1725x1721; color fundus image; FOV: 45 degrees: 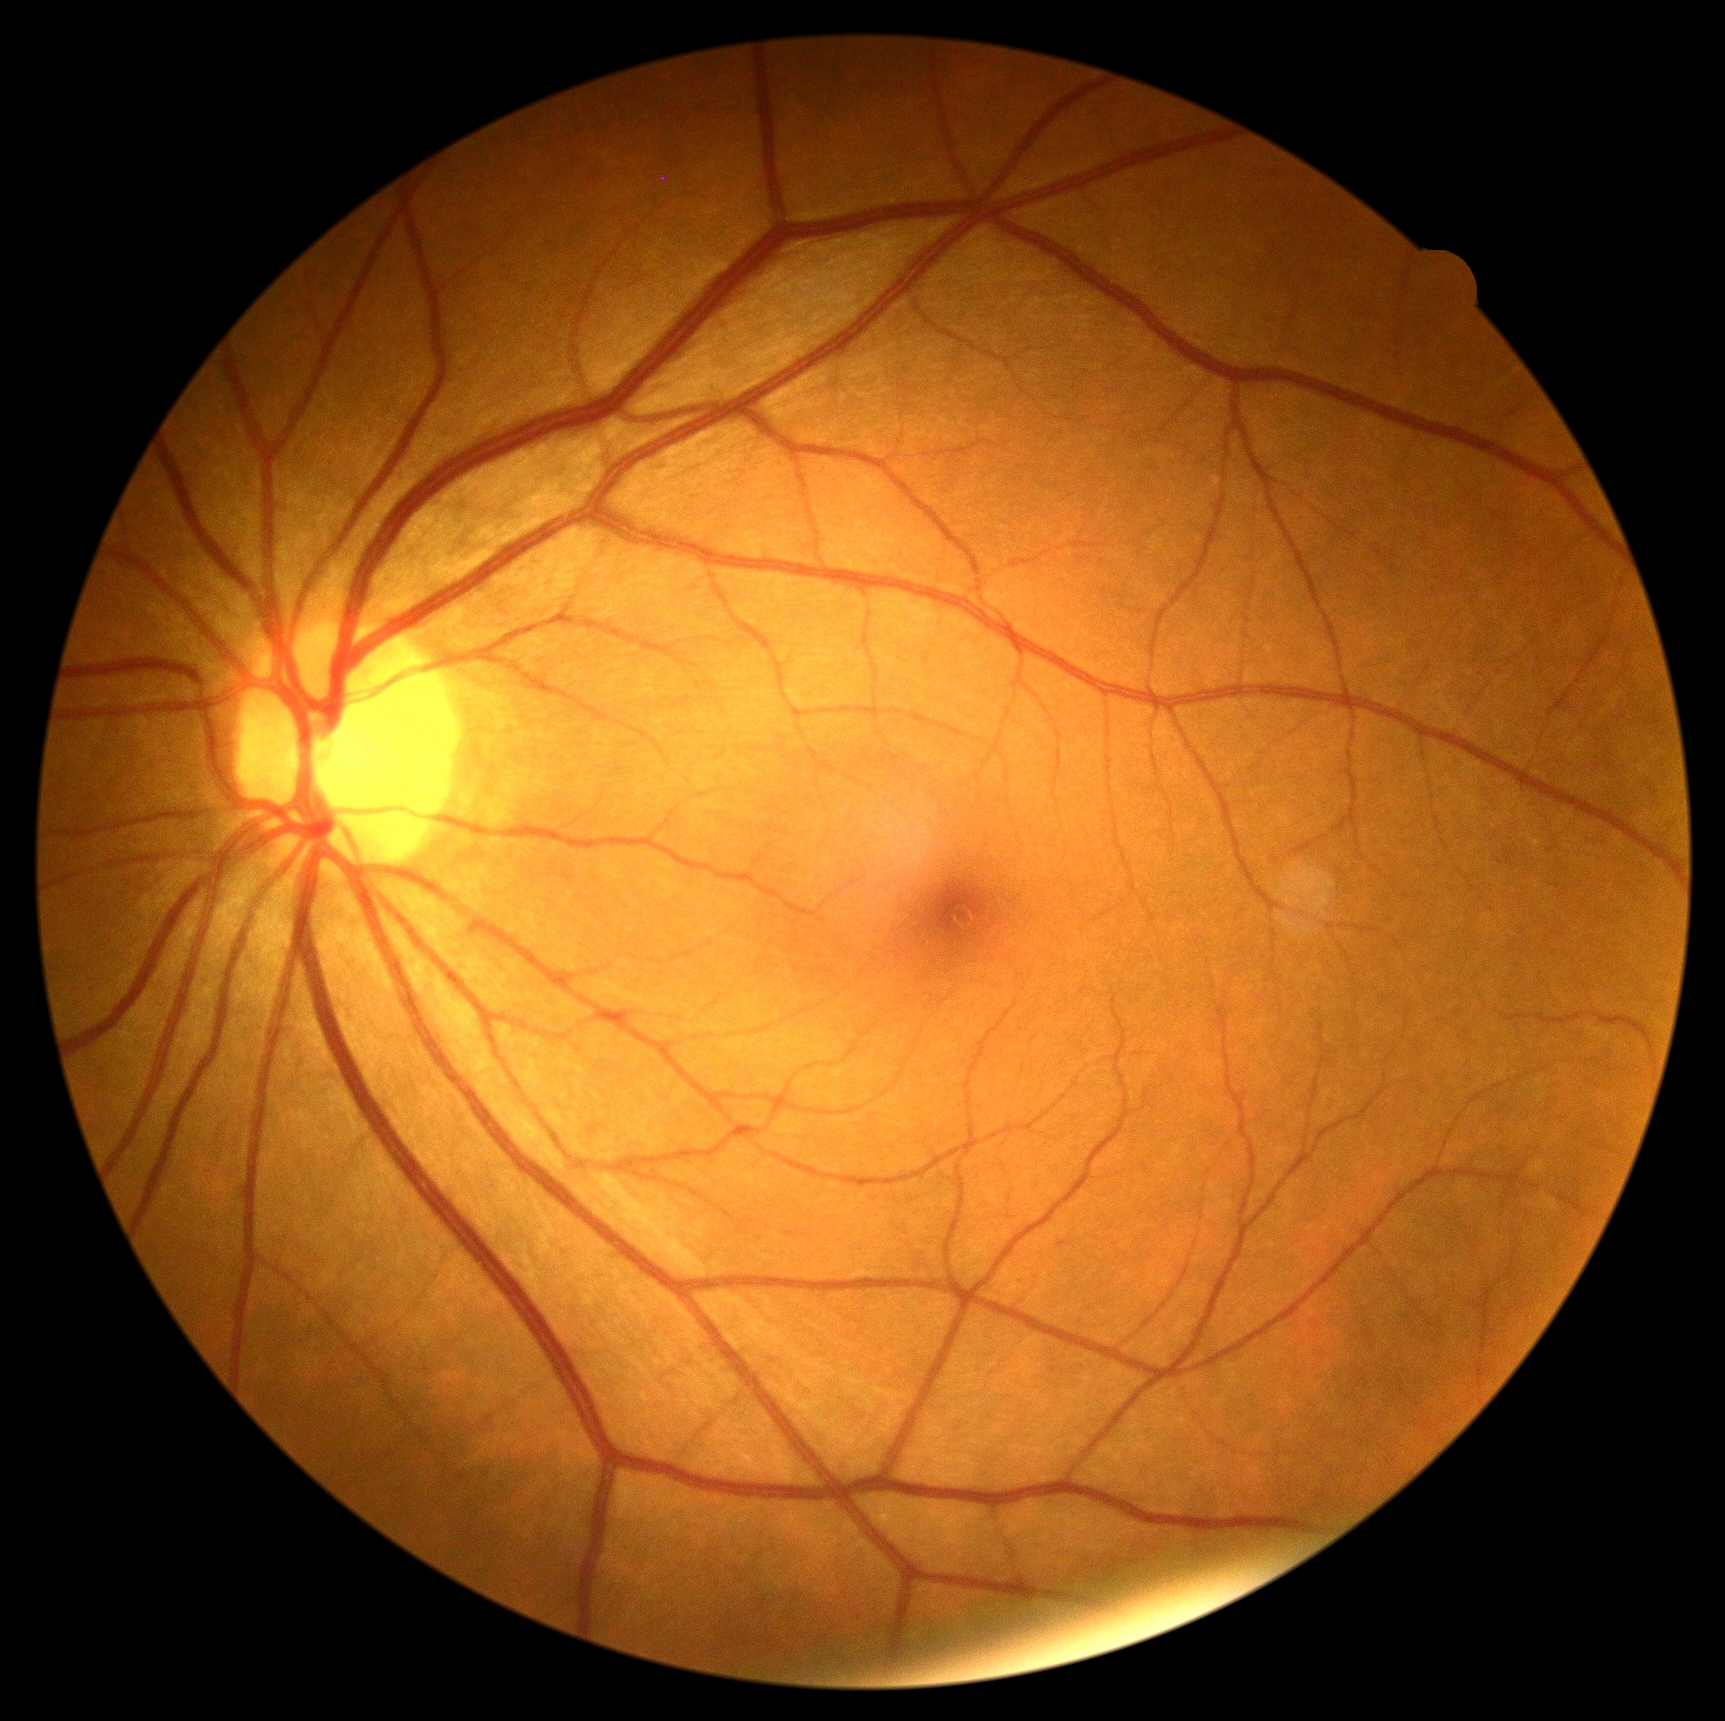 dr_impression: negative for DR
dr_grade: 0 (no apparent retinopathy)